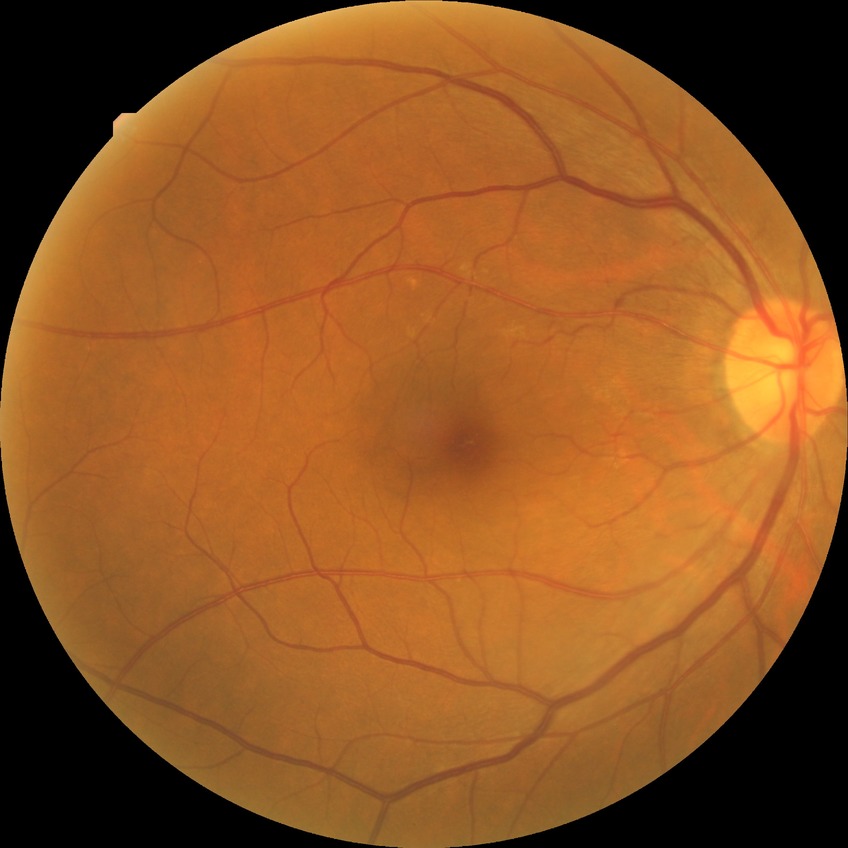 No diabetic retinal disease findings. DR: NDR.